45° field of view, color fundus image, image size 1932x1916: 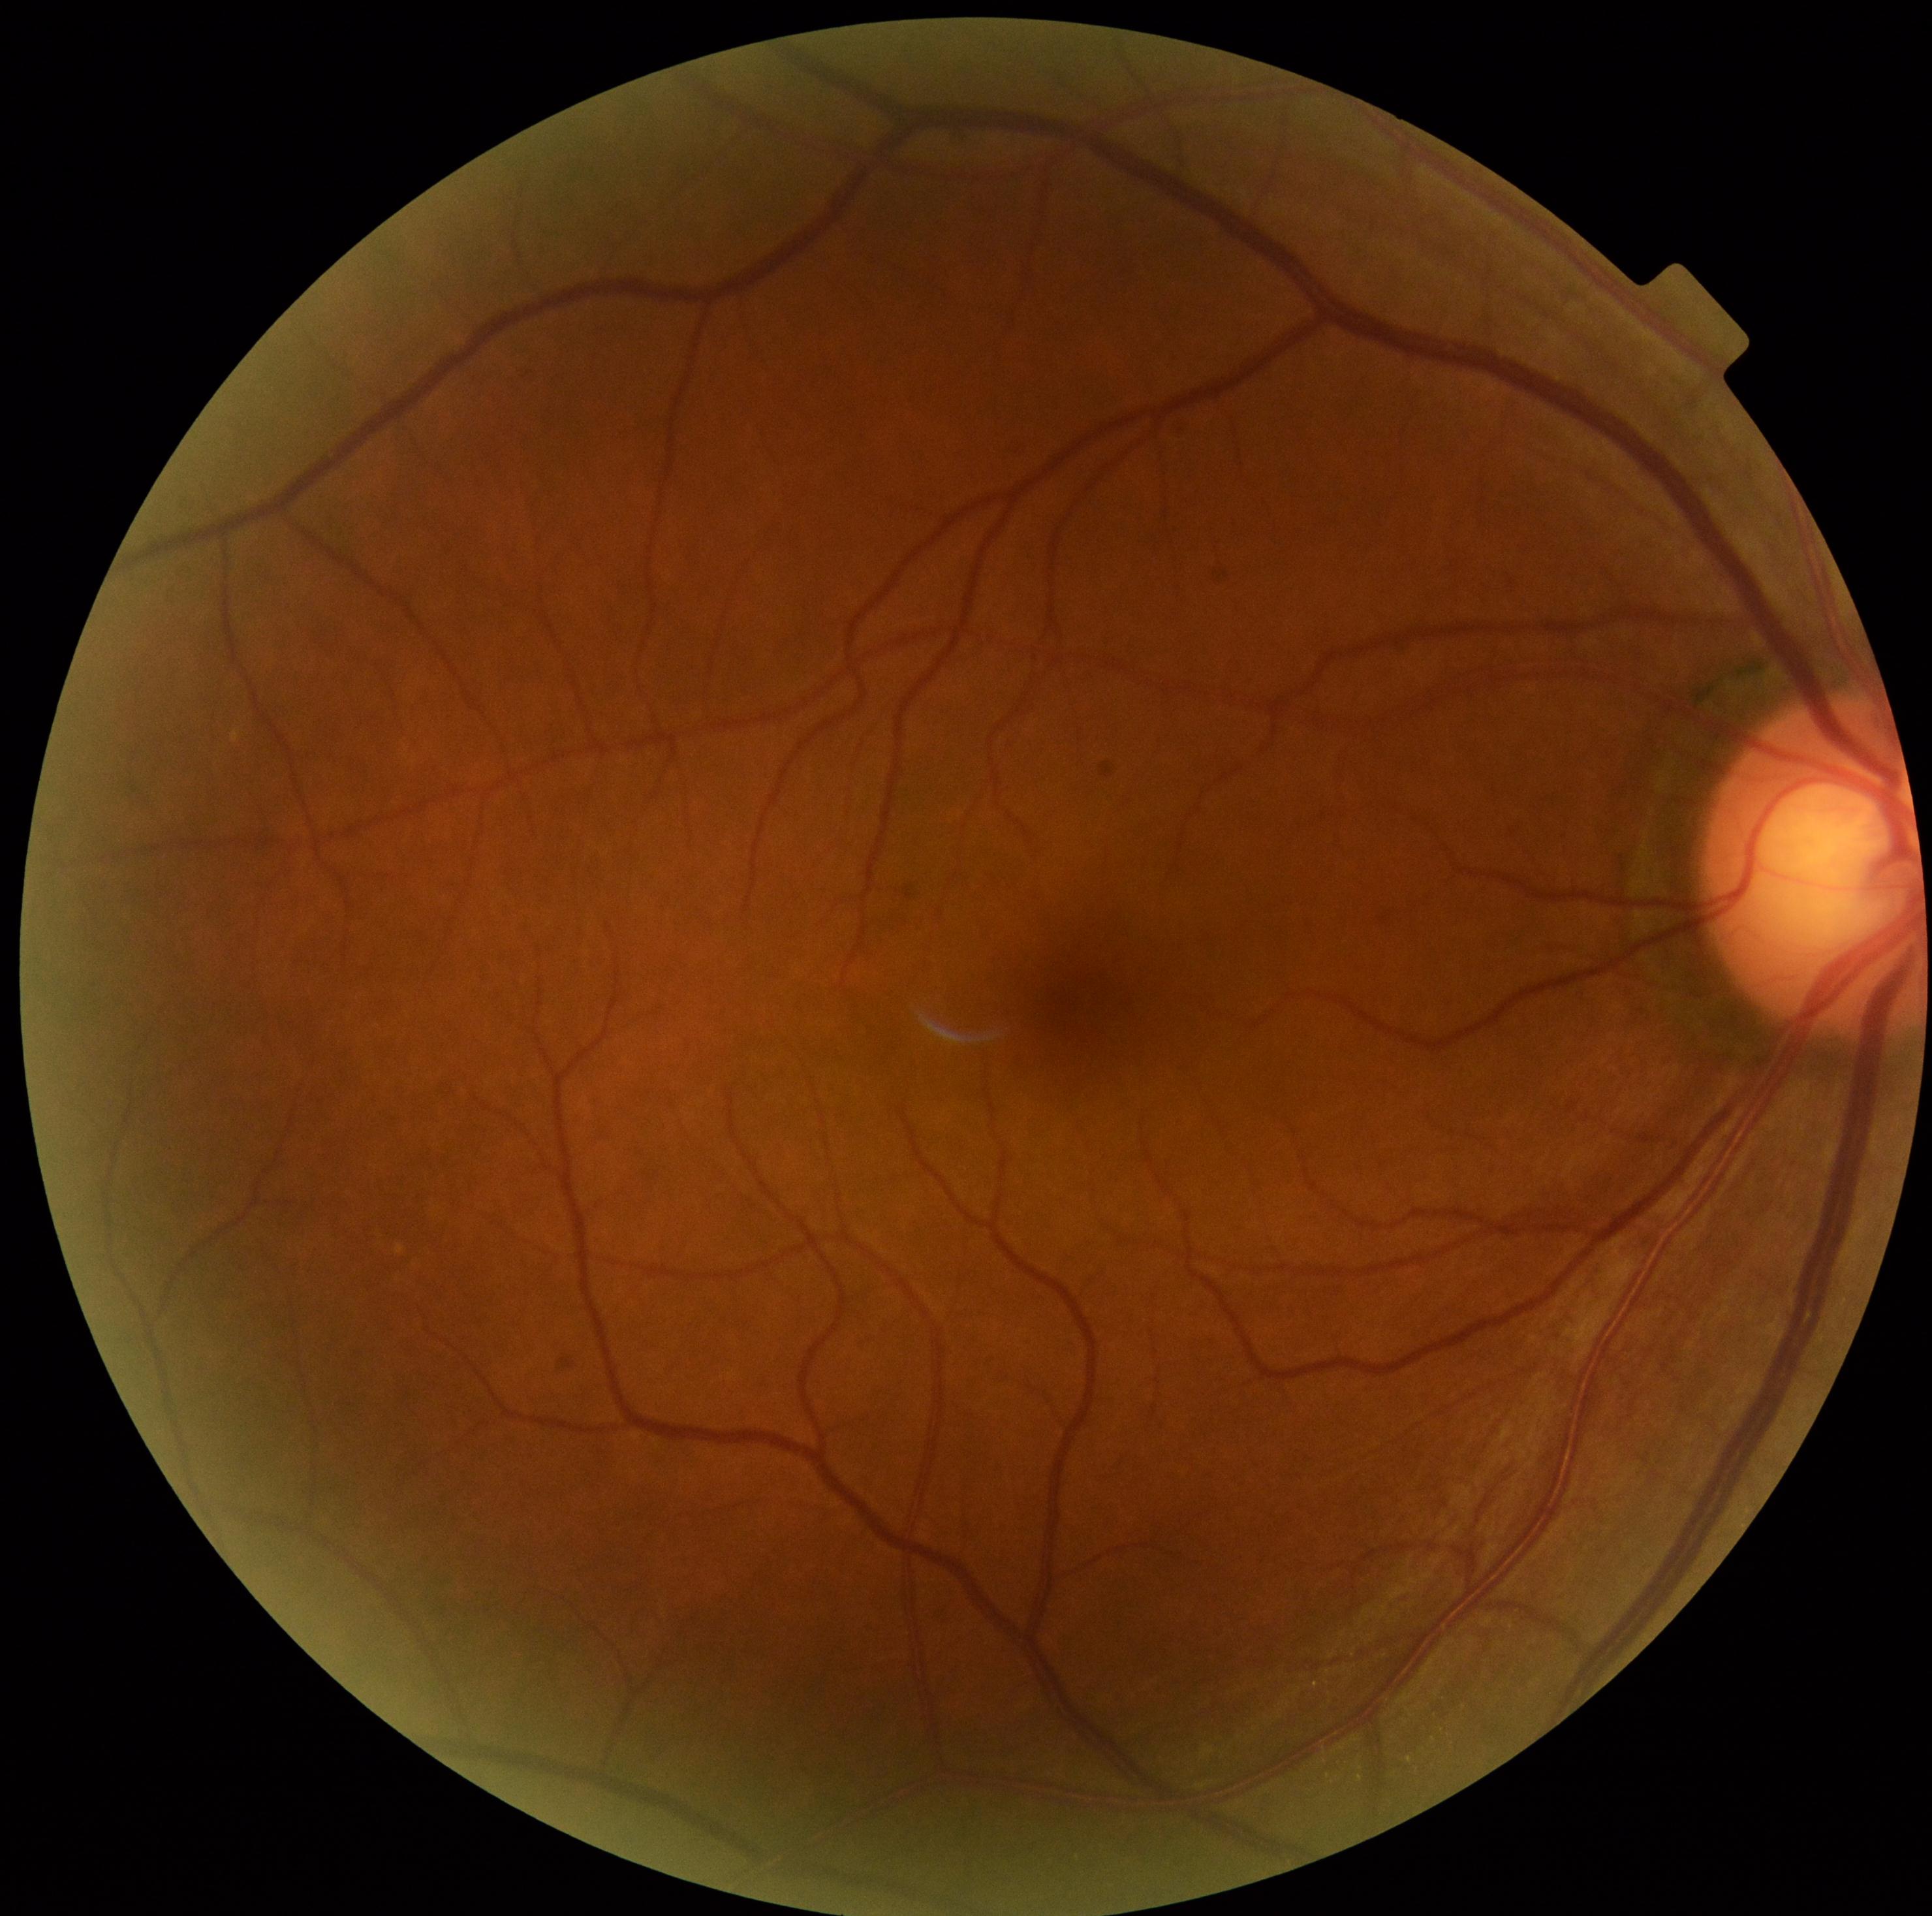

Retinopathy: grade 0 (no apparent retinopathy).